45 degree fundus photograph: 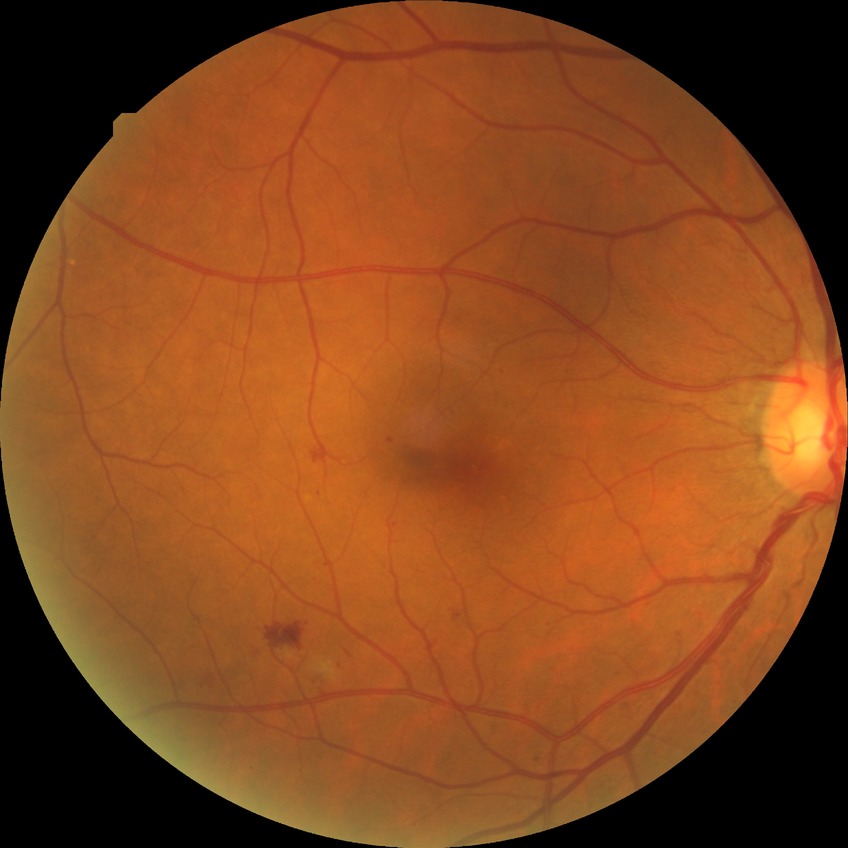

Davis grading is simple diabetic retinopathy.